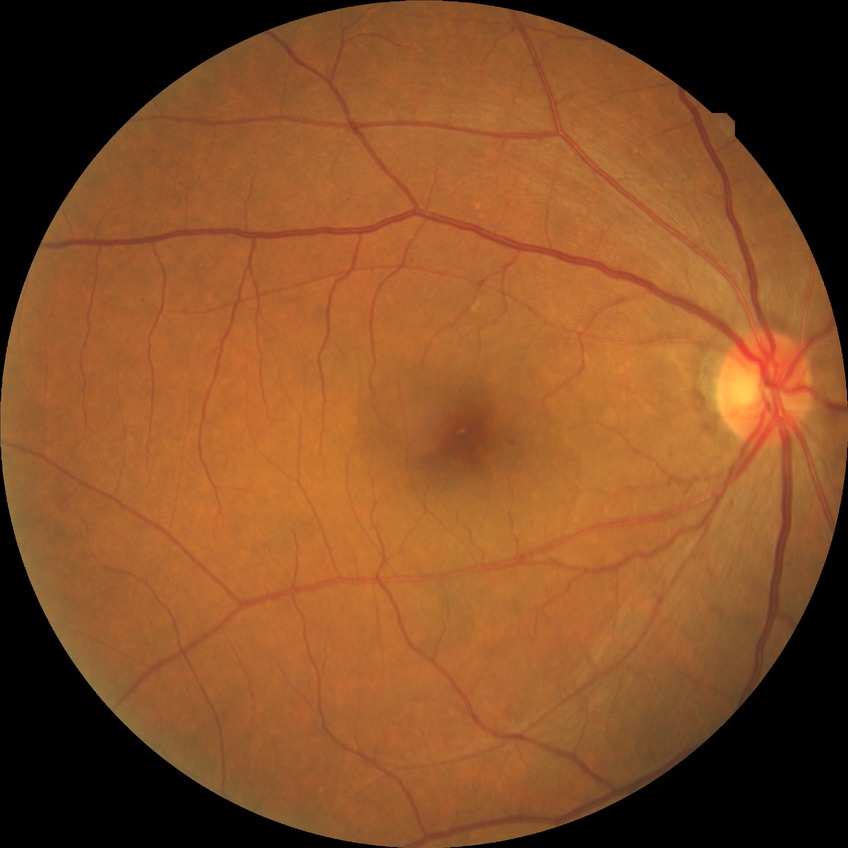

Diabetic retinopathy (DR) is no diabetic retinopathy (NDR).